Retinal fundus photograph; 848x848 — 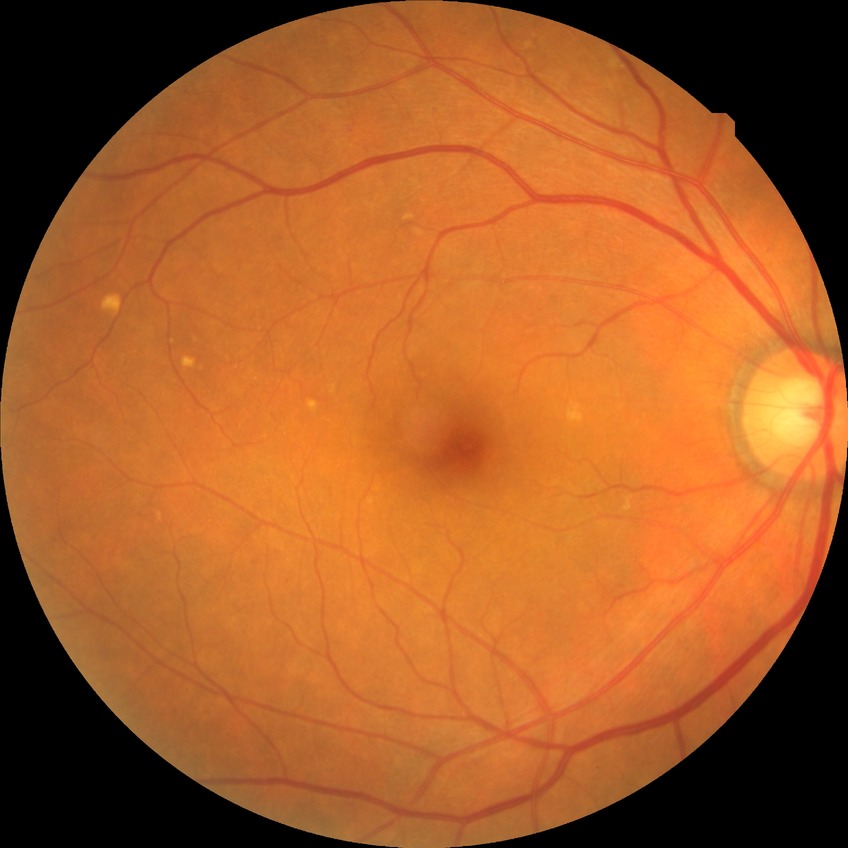 Diabetic retinopathy (DR) is simple diabetic retinopathy (SDR).